Infant wide-field retinal image:
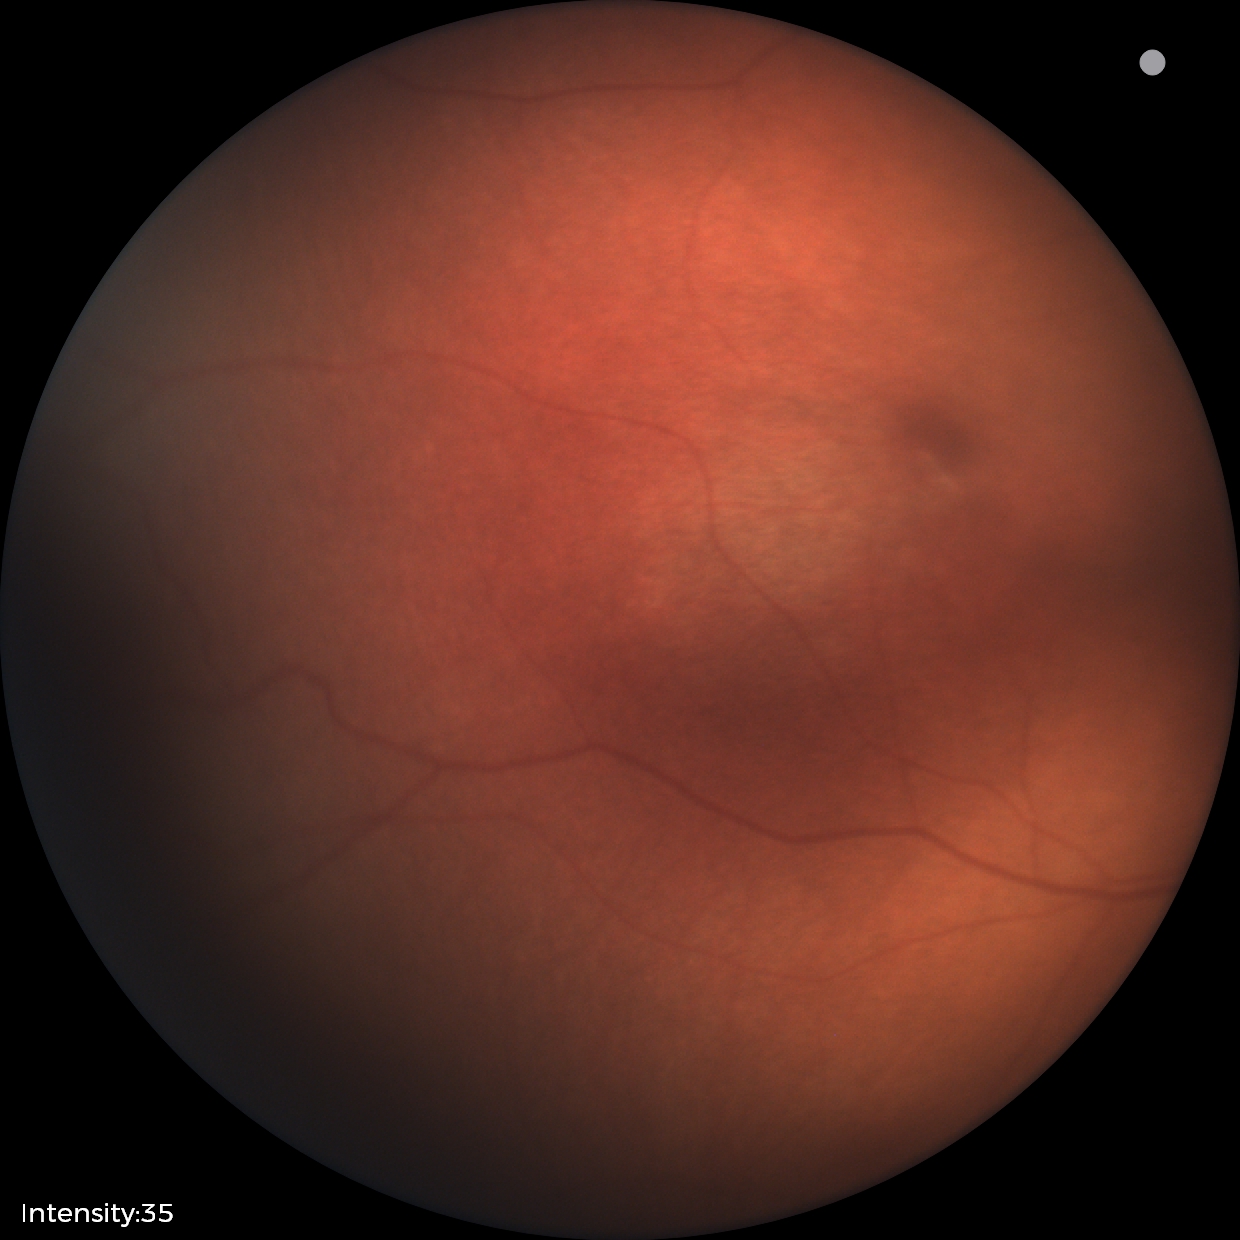

Impression: physiological retinal finding.